1380x1382px · color fundus image — 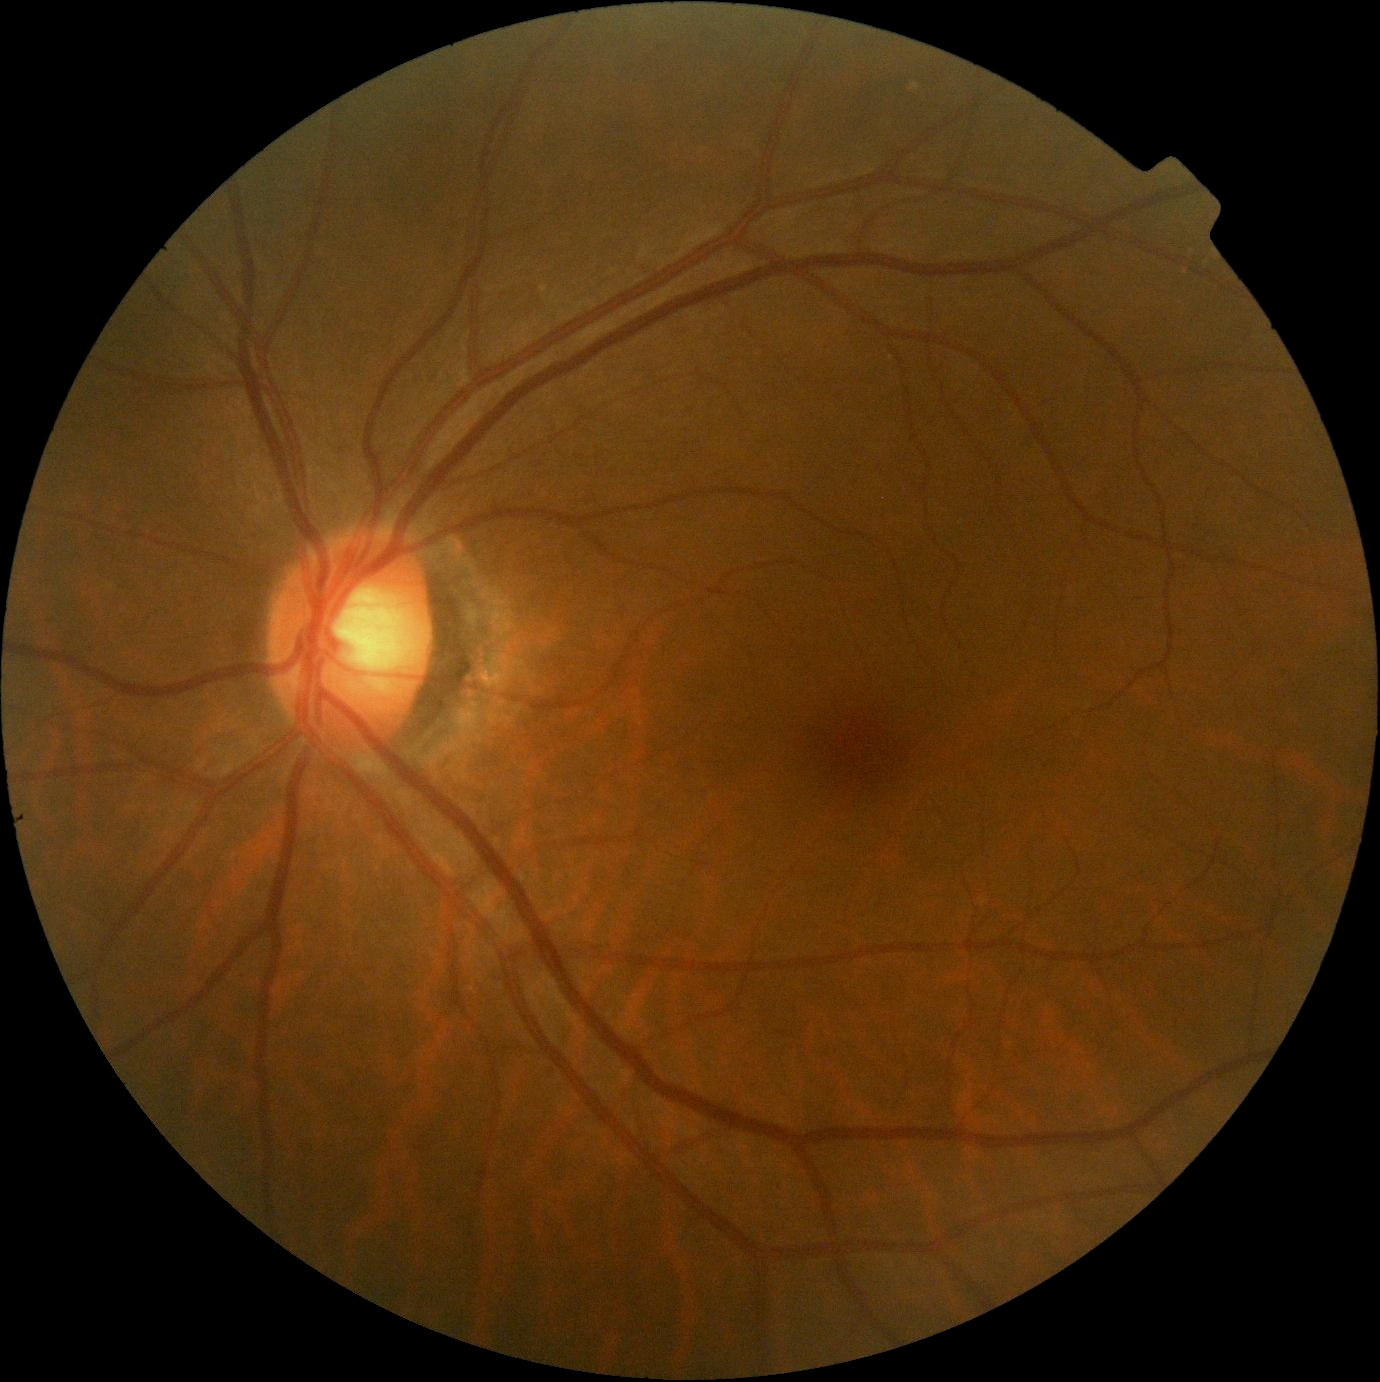

No signs of diabetic retinopathy. DR stage: grade 0 — no visible signs of diabetic retinopathy.